Image size 2352x1568:
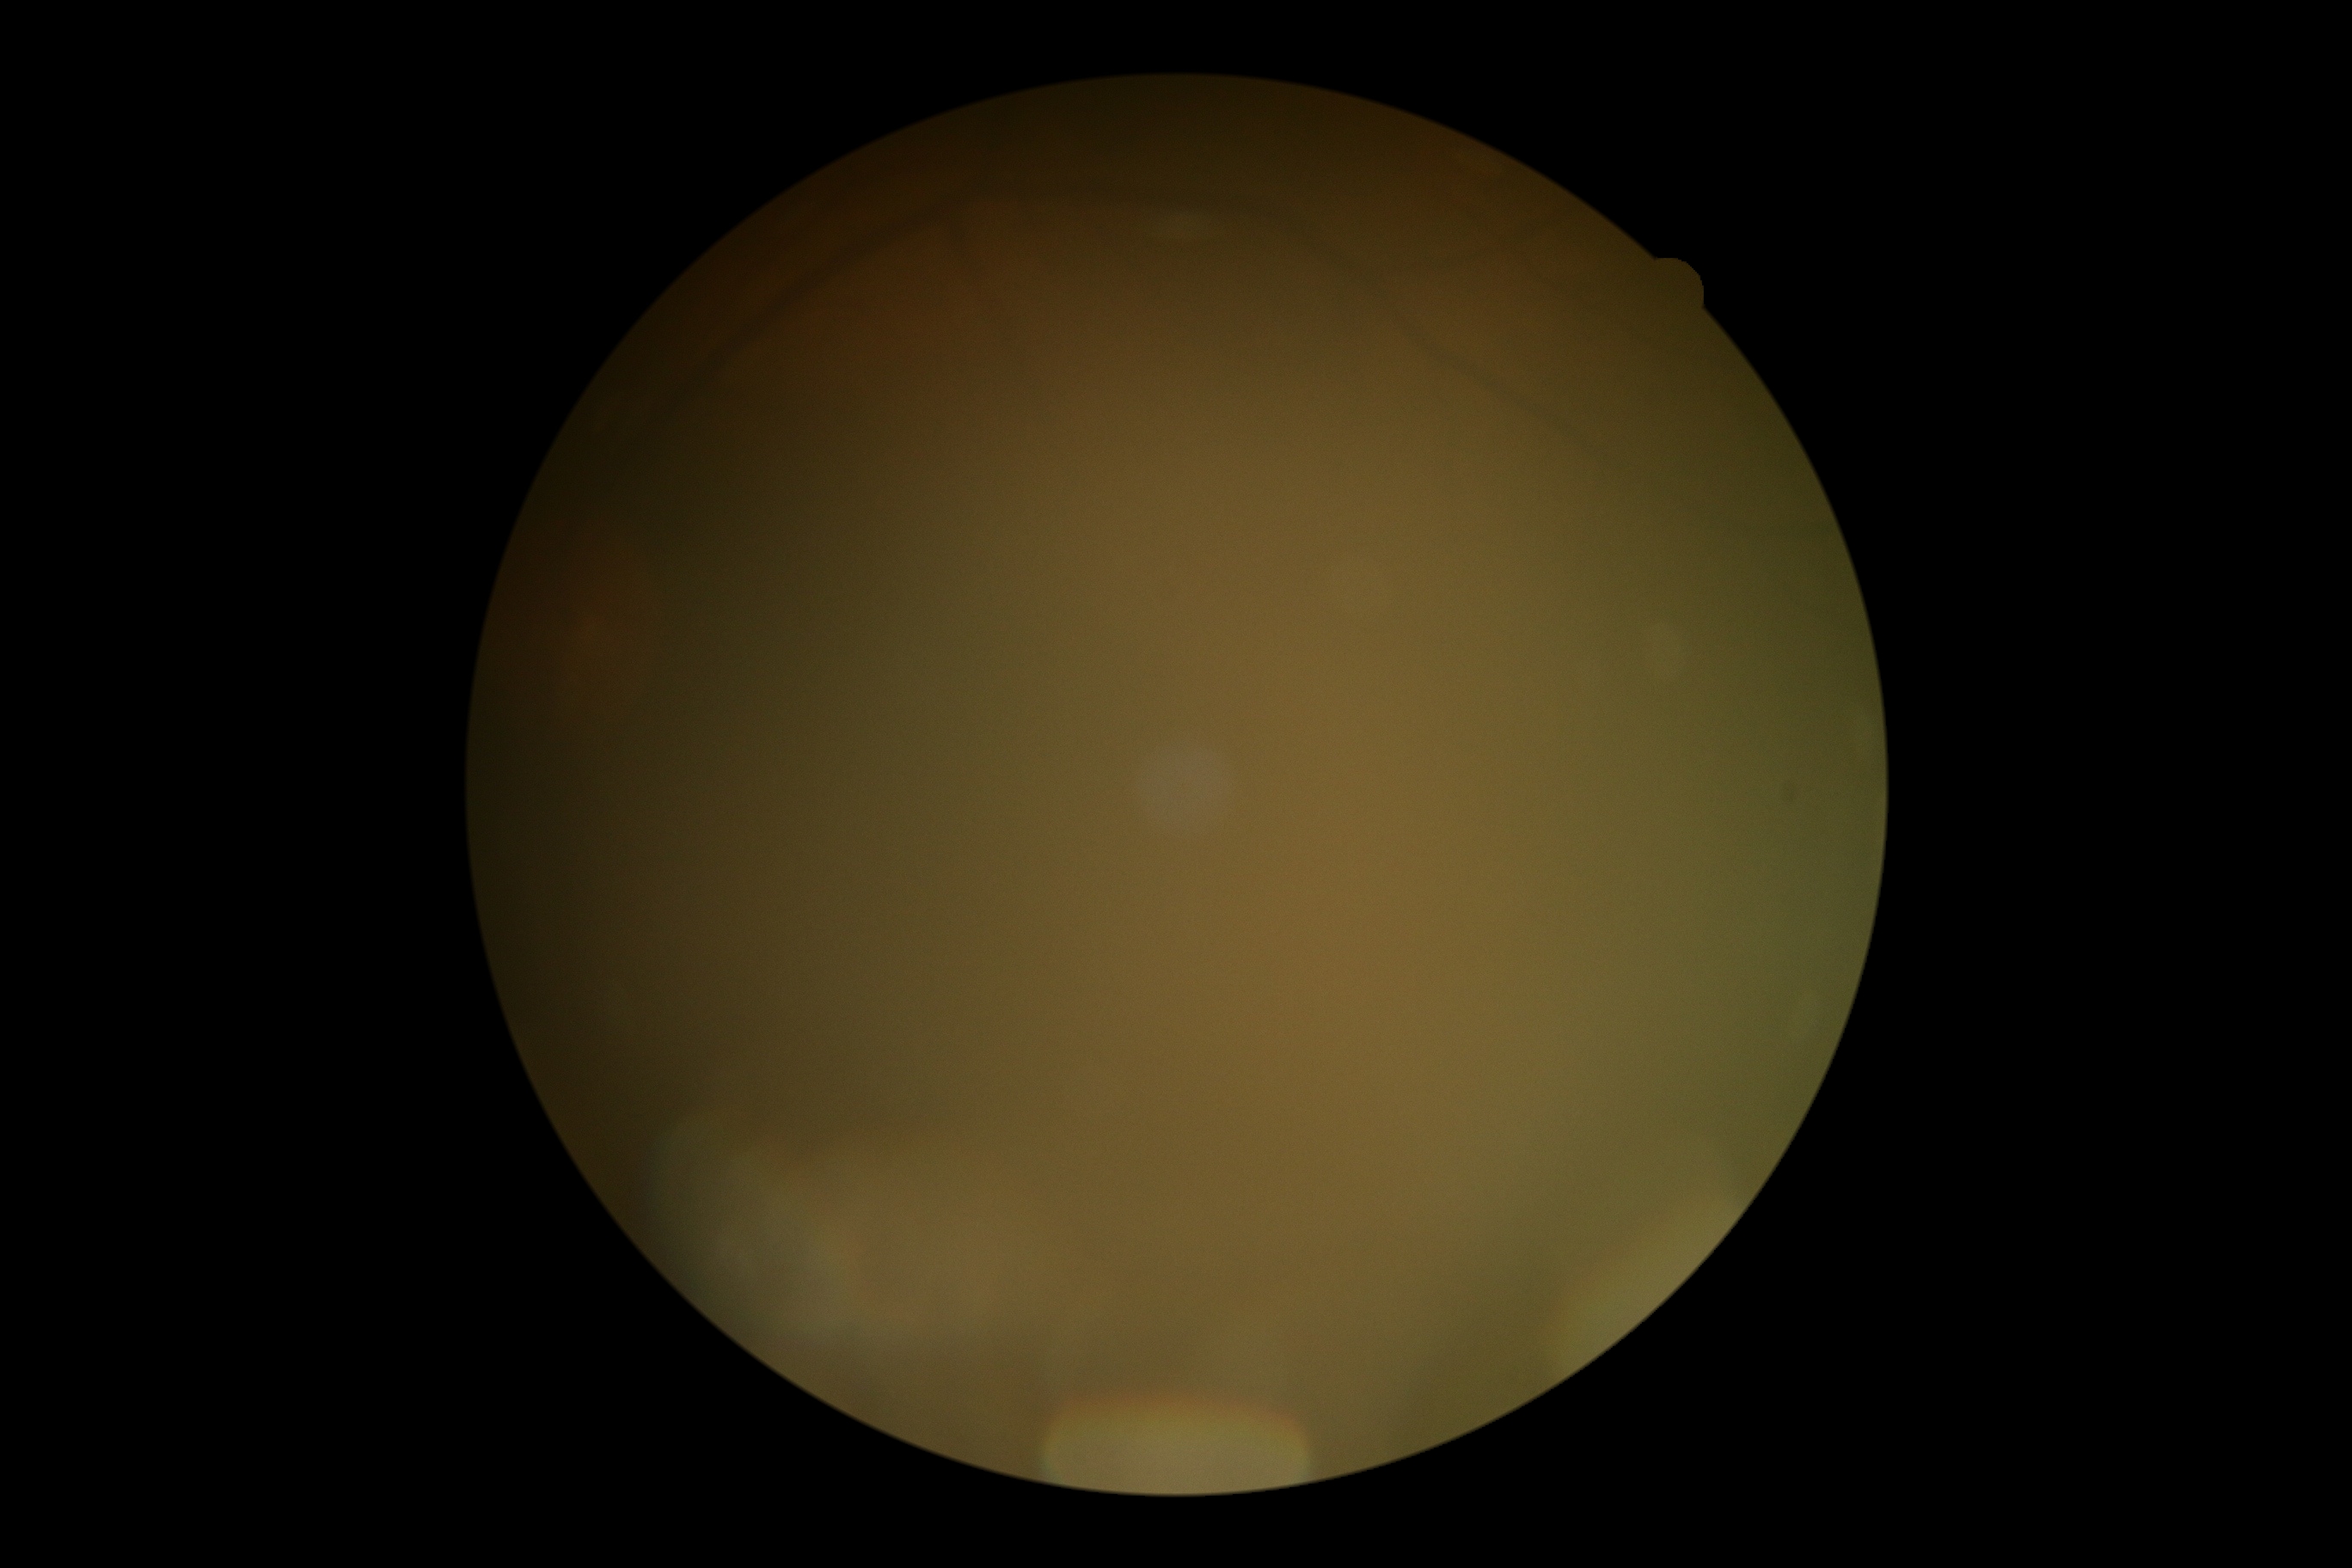

DR severity: ungradable. Image quality is insufficient for diabetic retinopathy assessment.